45-degree field of view, color fundus image: 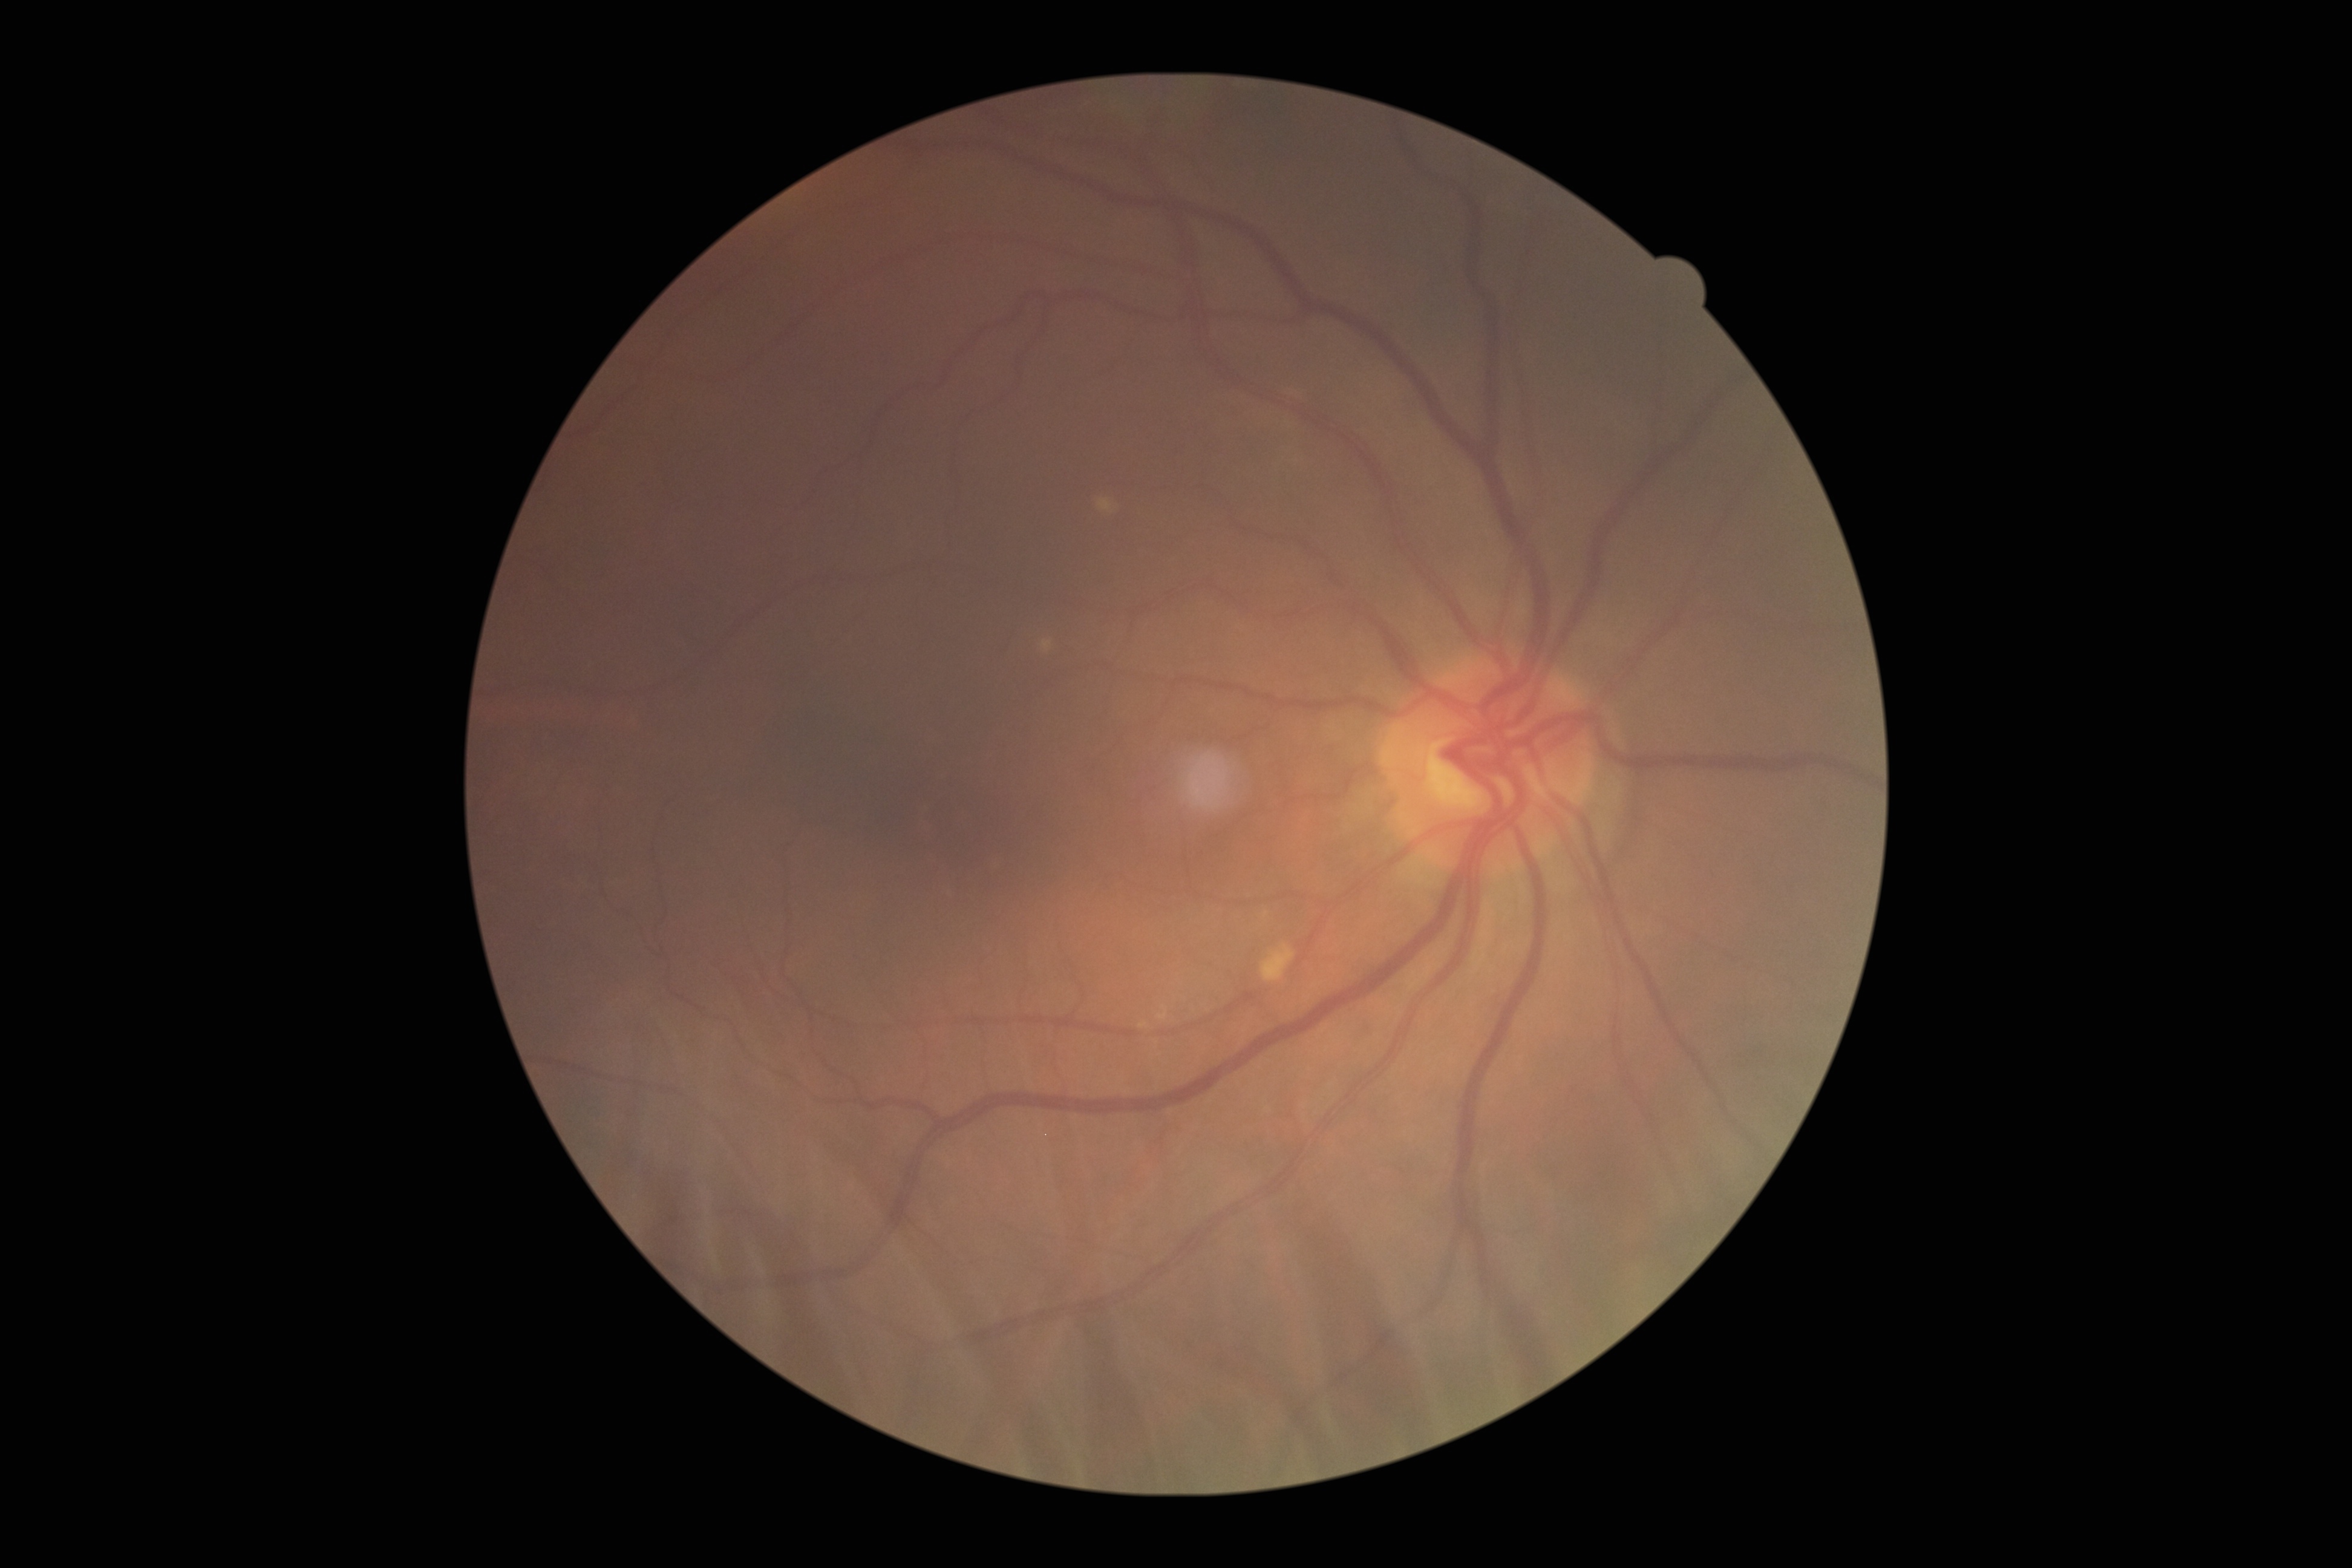
Diabetic retinopathy (DR) is 0/4 — no visible signs of diabetic retinopathy.